1659x2212 · CFP · captured on a Remidio Fundus on Phone (FOP) camera.
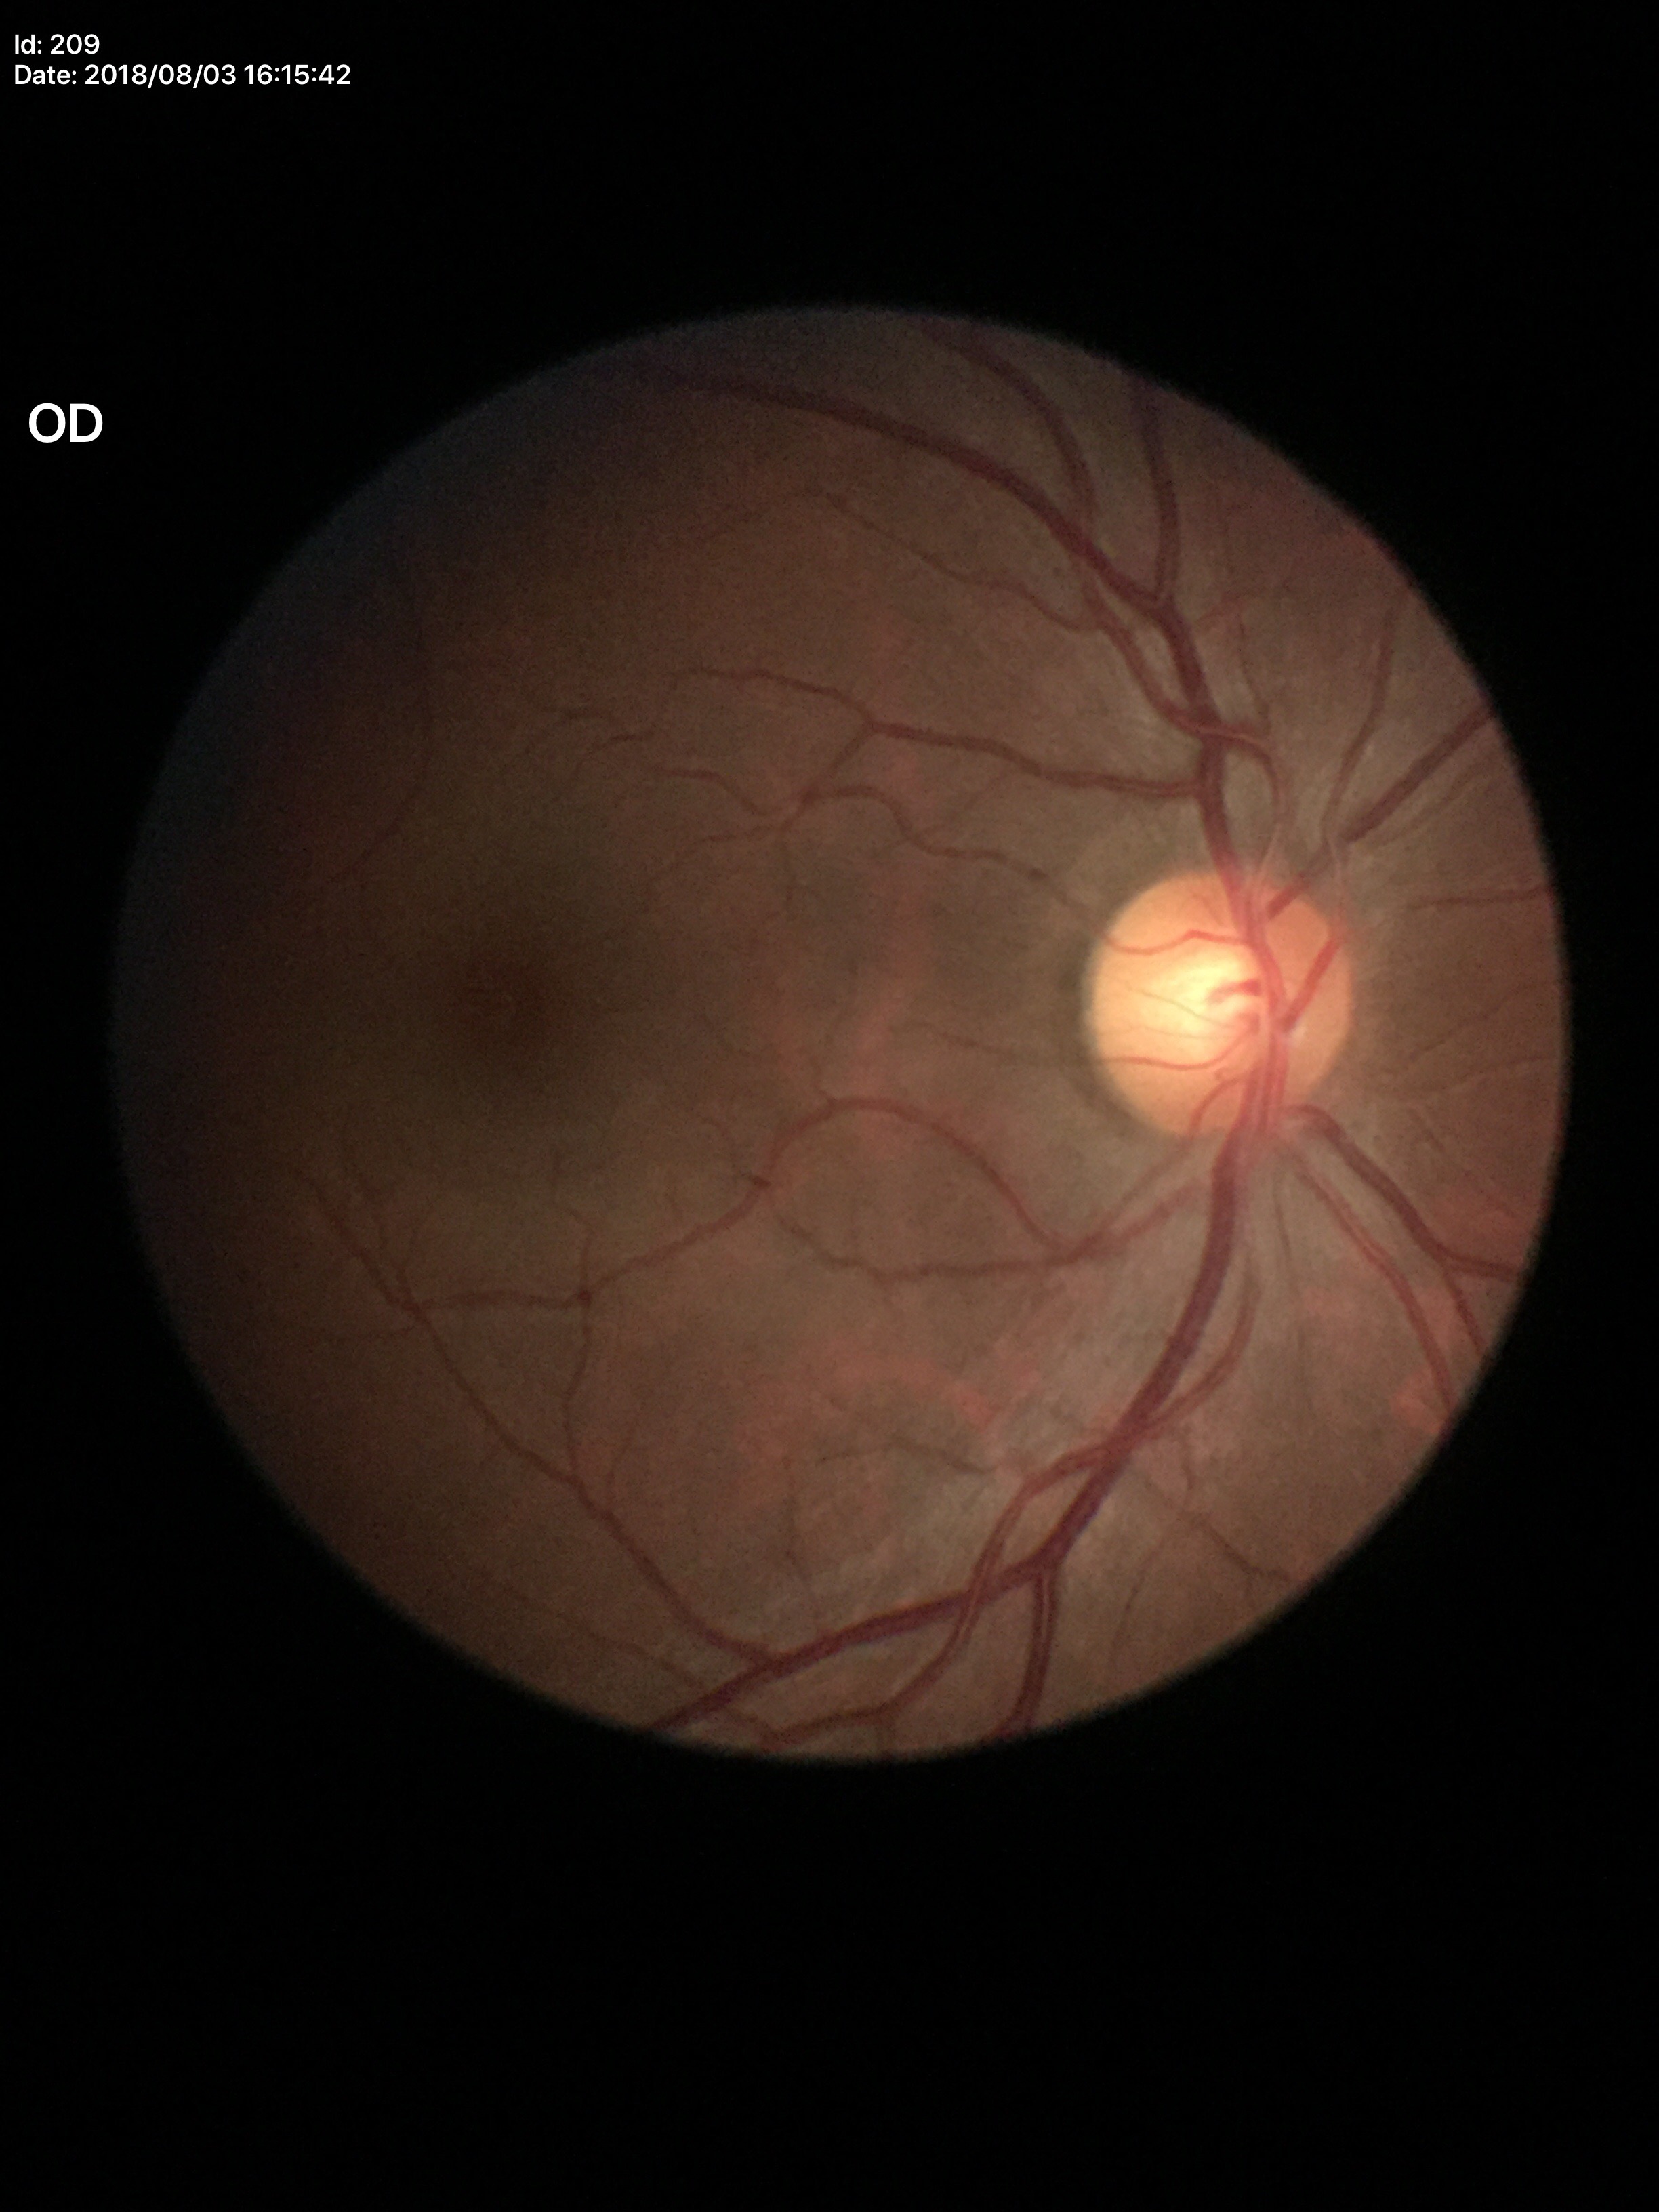 No glaucomatous optic neuropathy (unanimous normal call). Vertical C/D ratio is 0.50.